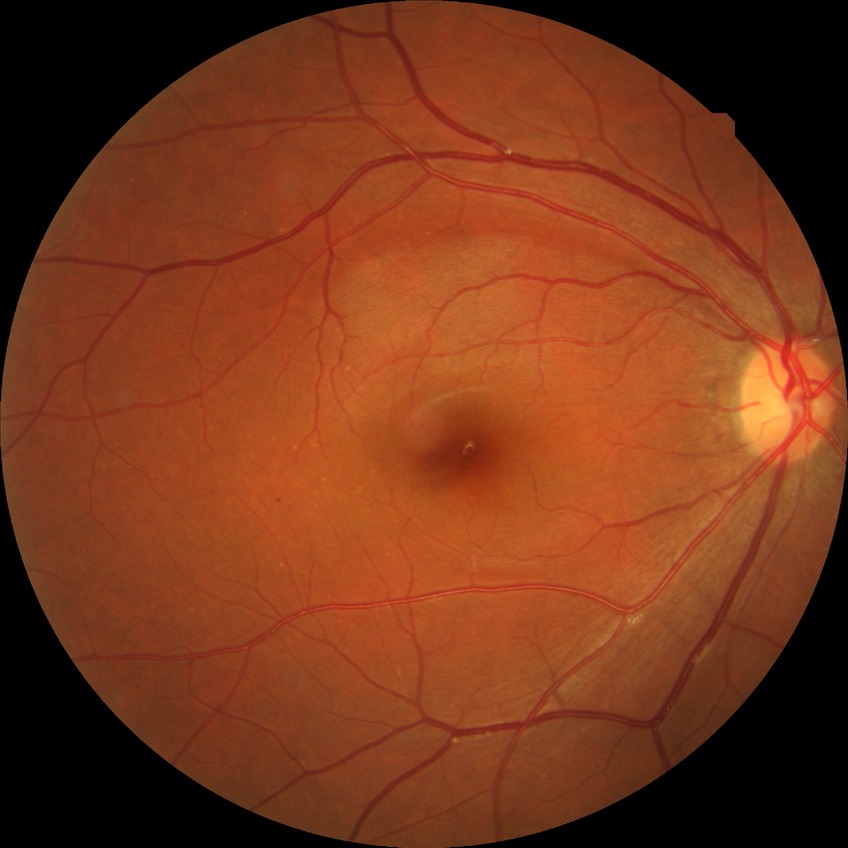 Diabetic retinopathy (DR): SDR (simple diabetic retinopathy).